CFP; 2212x1672 — 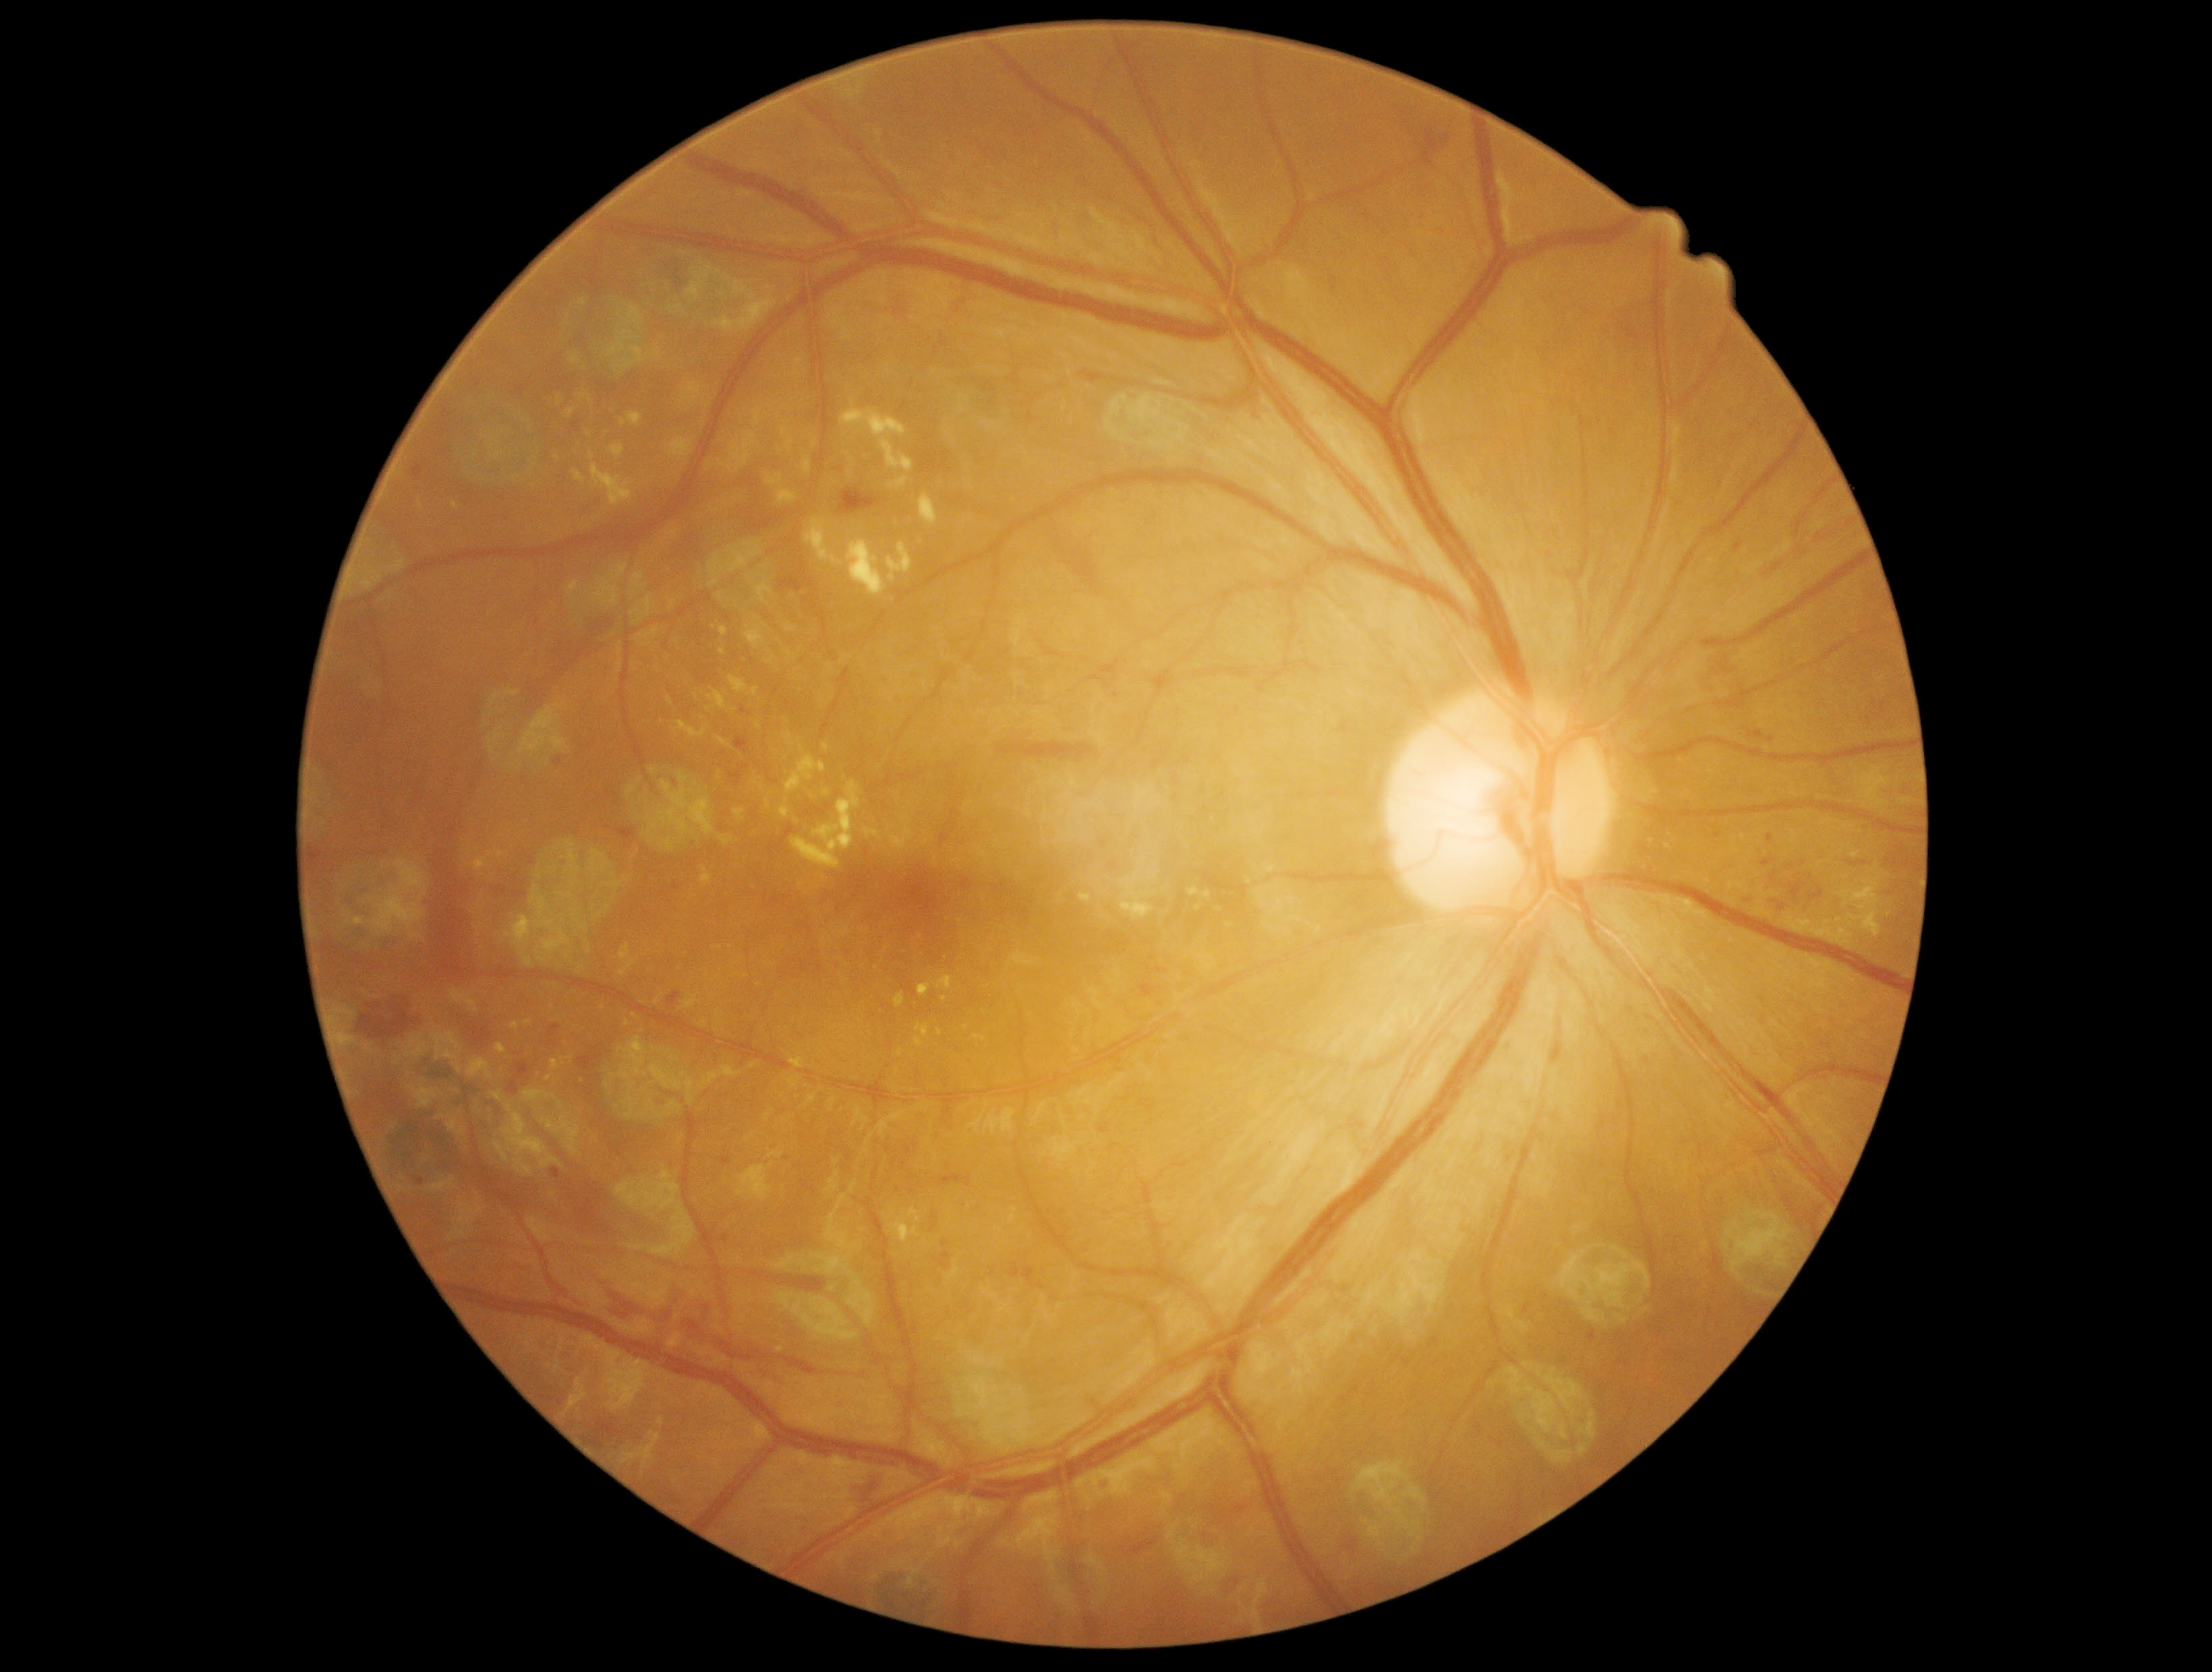
diabetic retinopathy severity=2/4.